1240x1240; pediatric retinal photograph (wide-field) — 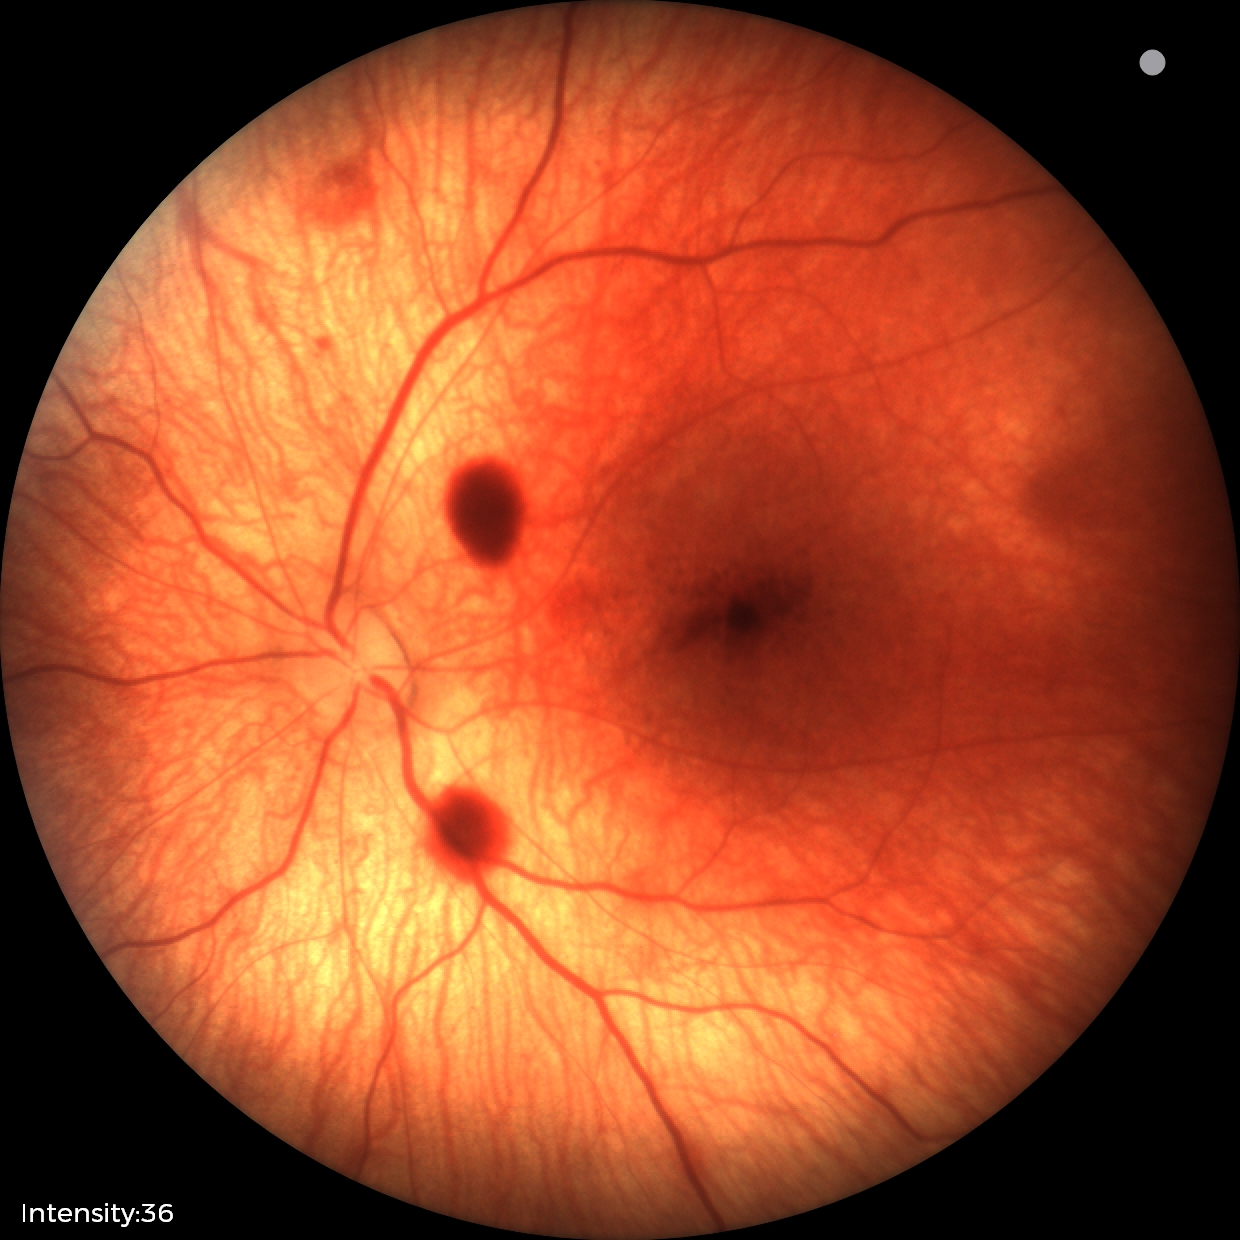 Q: What is the diagnosis from this examination?
A: retinal hemorrhages